Image size 848x848. Nonmydriatic fundus photograph — 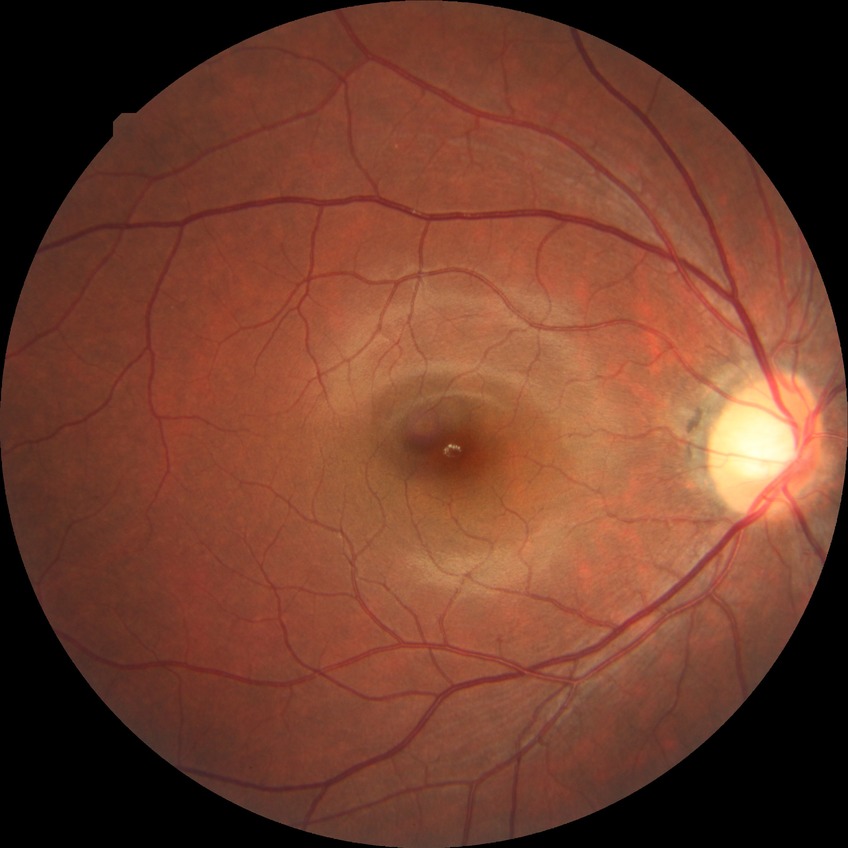
modified Davis classification: no diabetic retinopathy.